2352x1568px, FOV: 45 degrees, retinal fundus photograph — 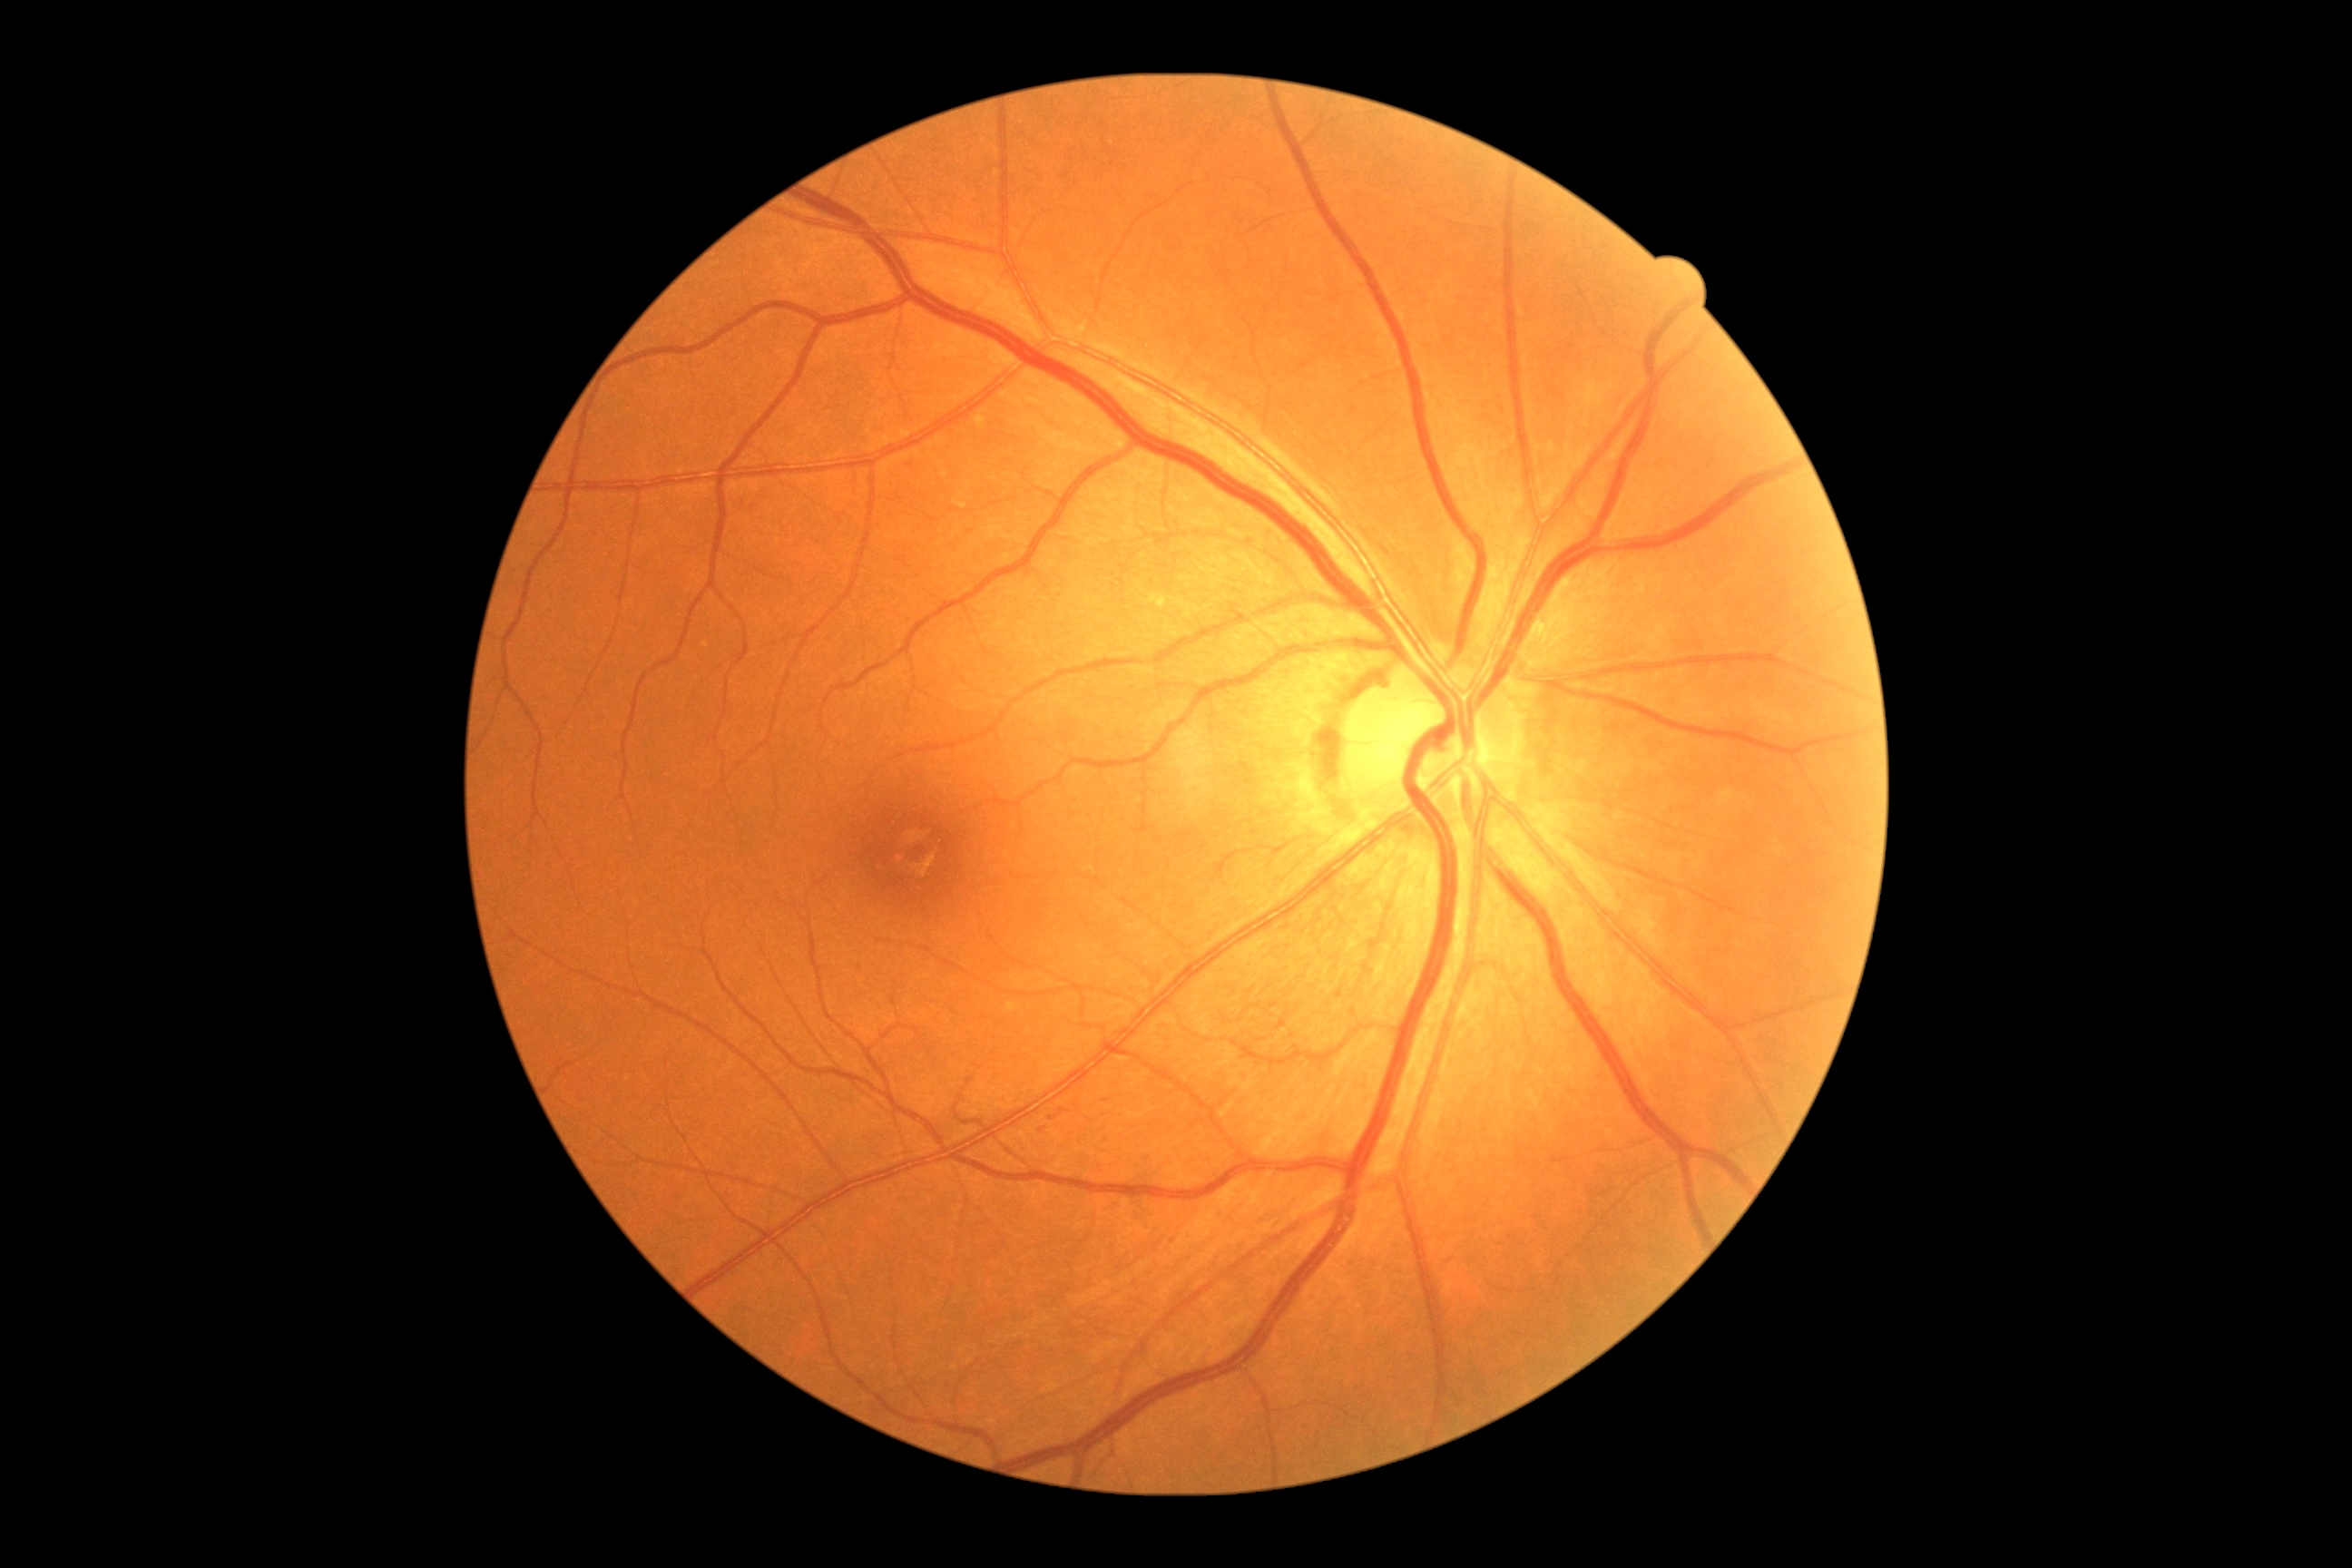 Diabetic retinopathy grade: 1 (mild NPDR).